240x240:
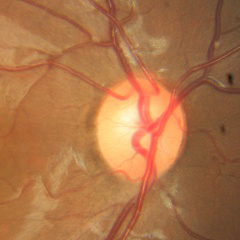 Color fundus photograph showing no glaucomatous optic neuropathy.